Image size 848x848:
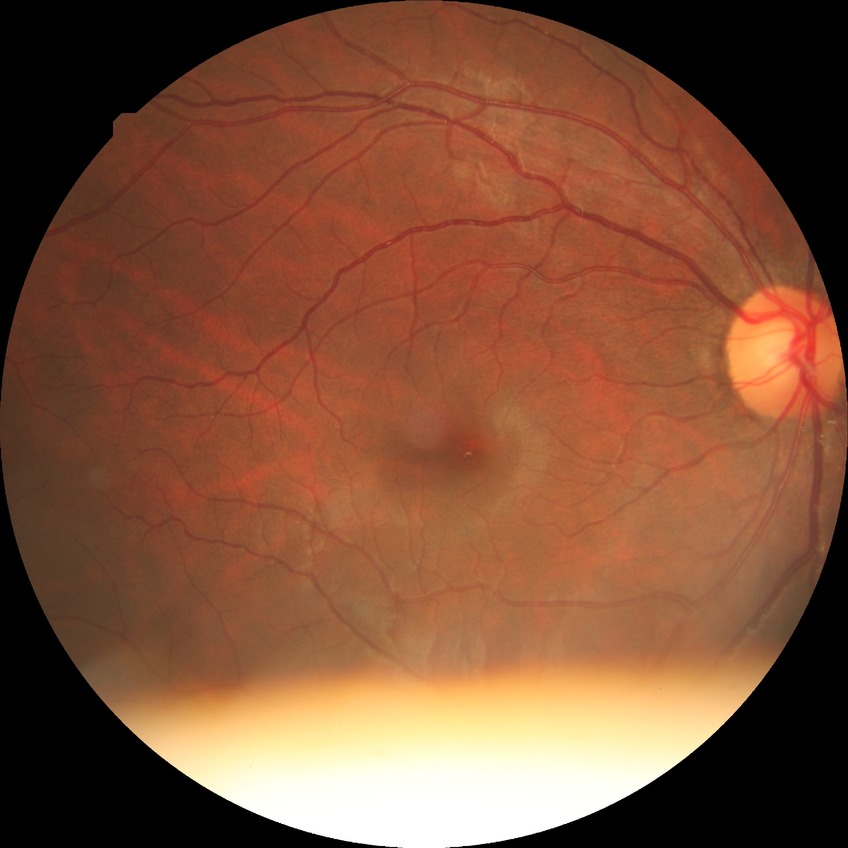

No apparent diabetic retinopathy. DR grade: NDR.